Centered on the optic disc · fundus photo
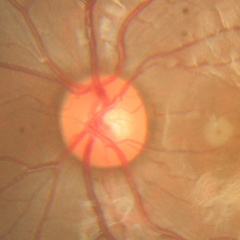
There is evidence of no signs of glaucoma.